Acquired with a NIDEK AFC-230; modified Davis grading:
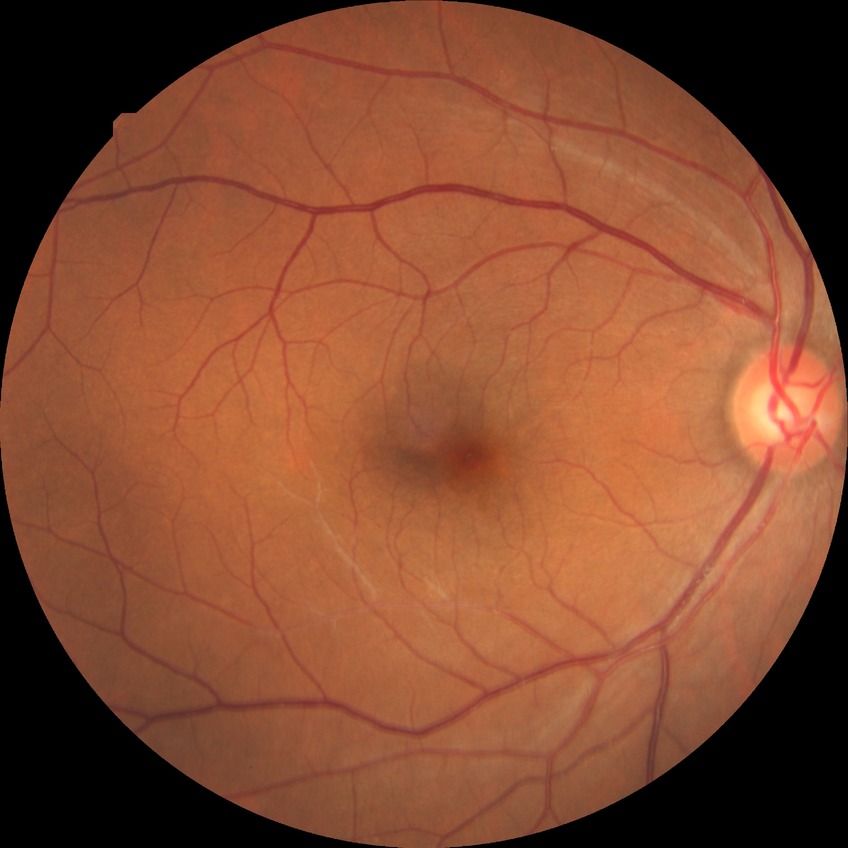

No DR findings. Modified Davis grade is NDR.